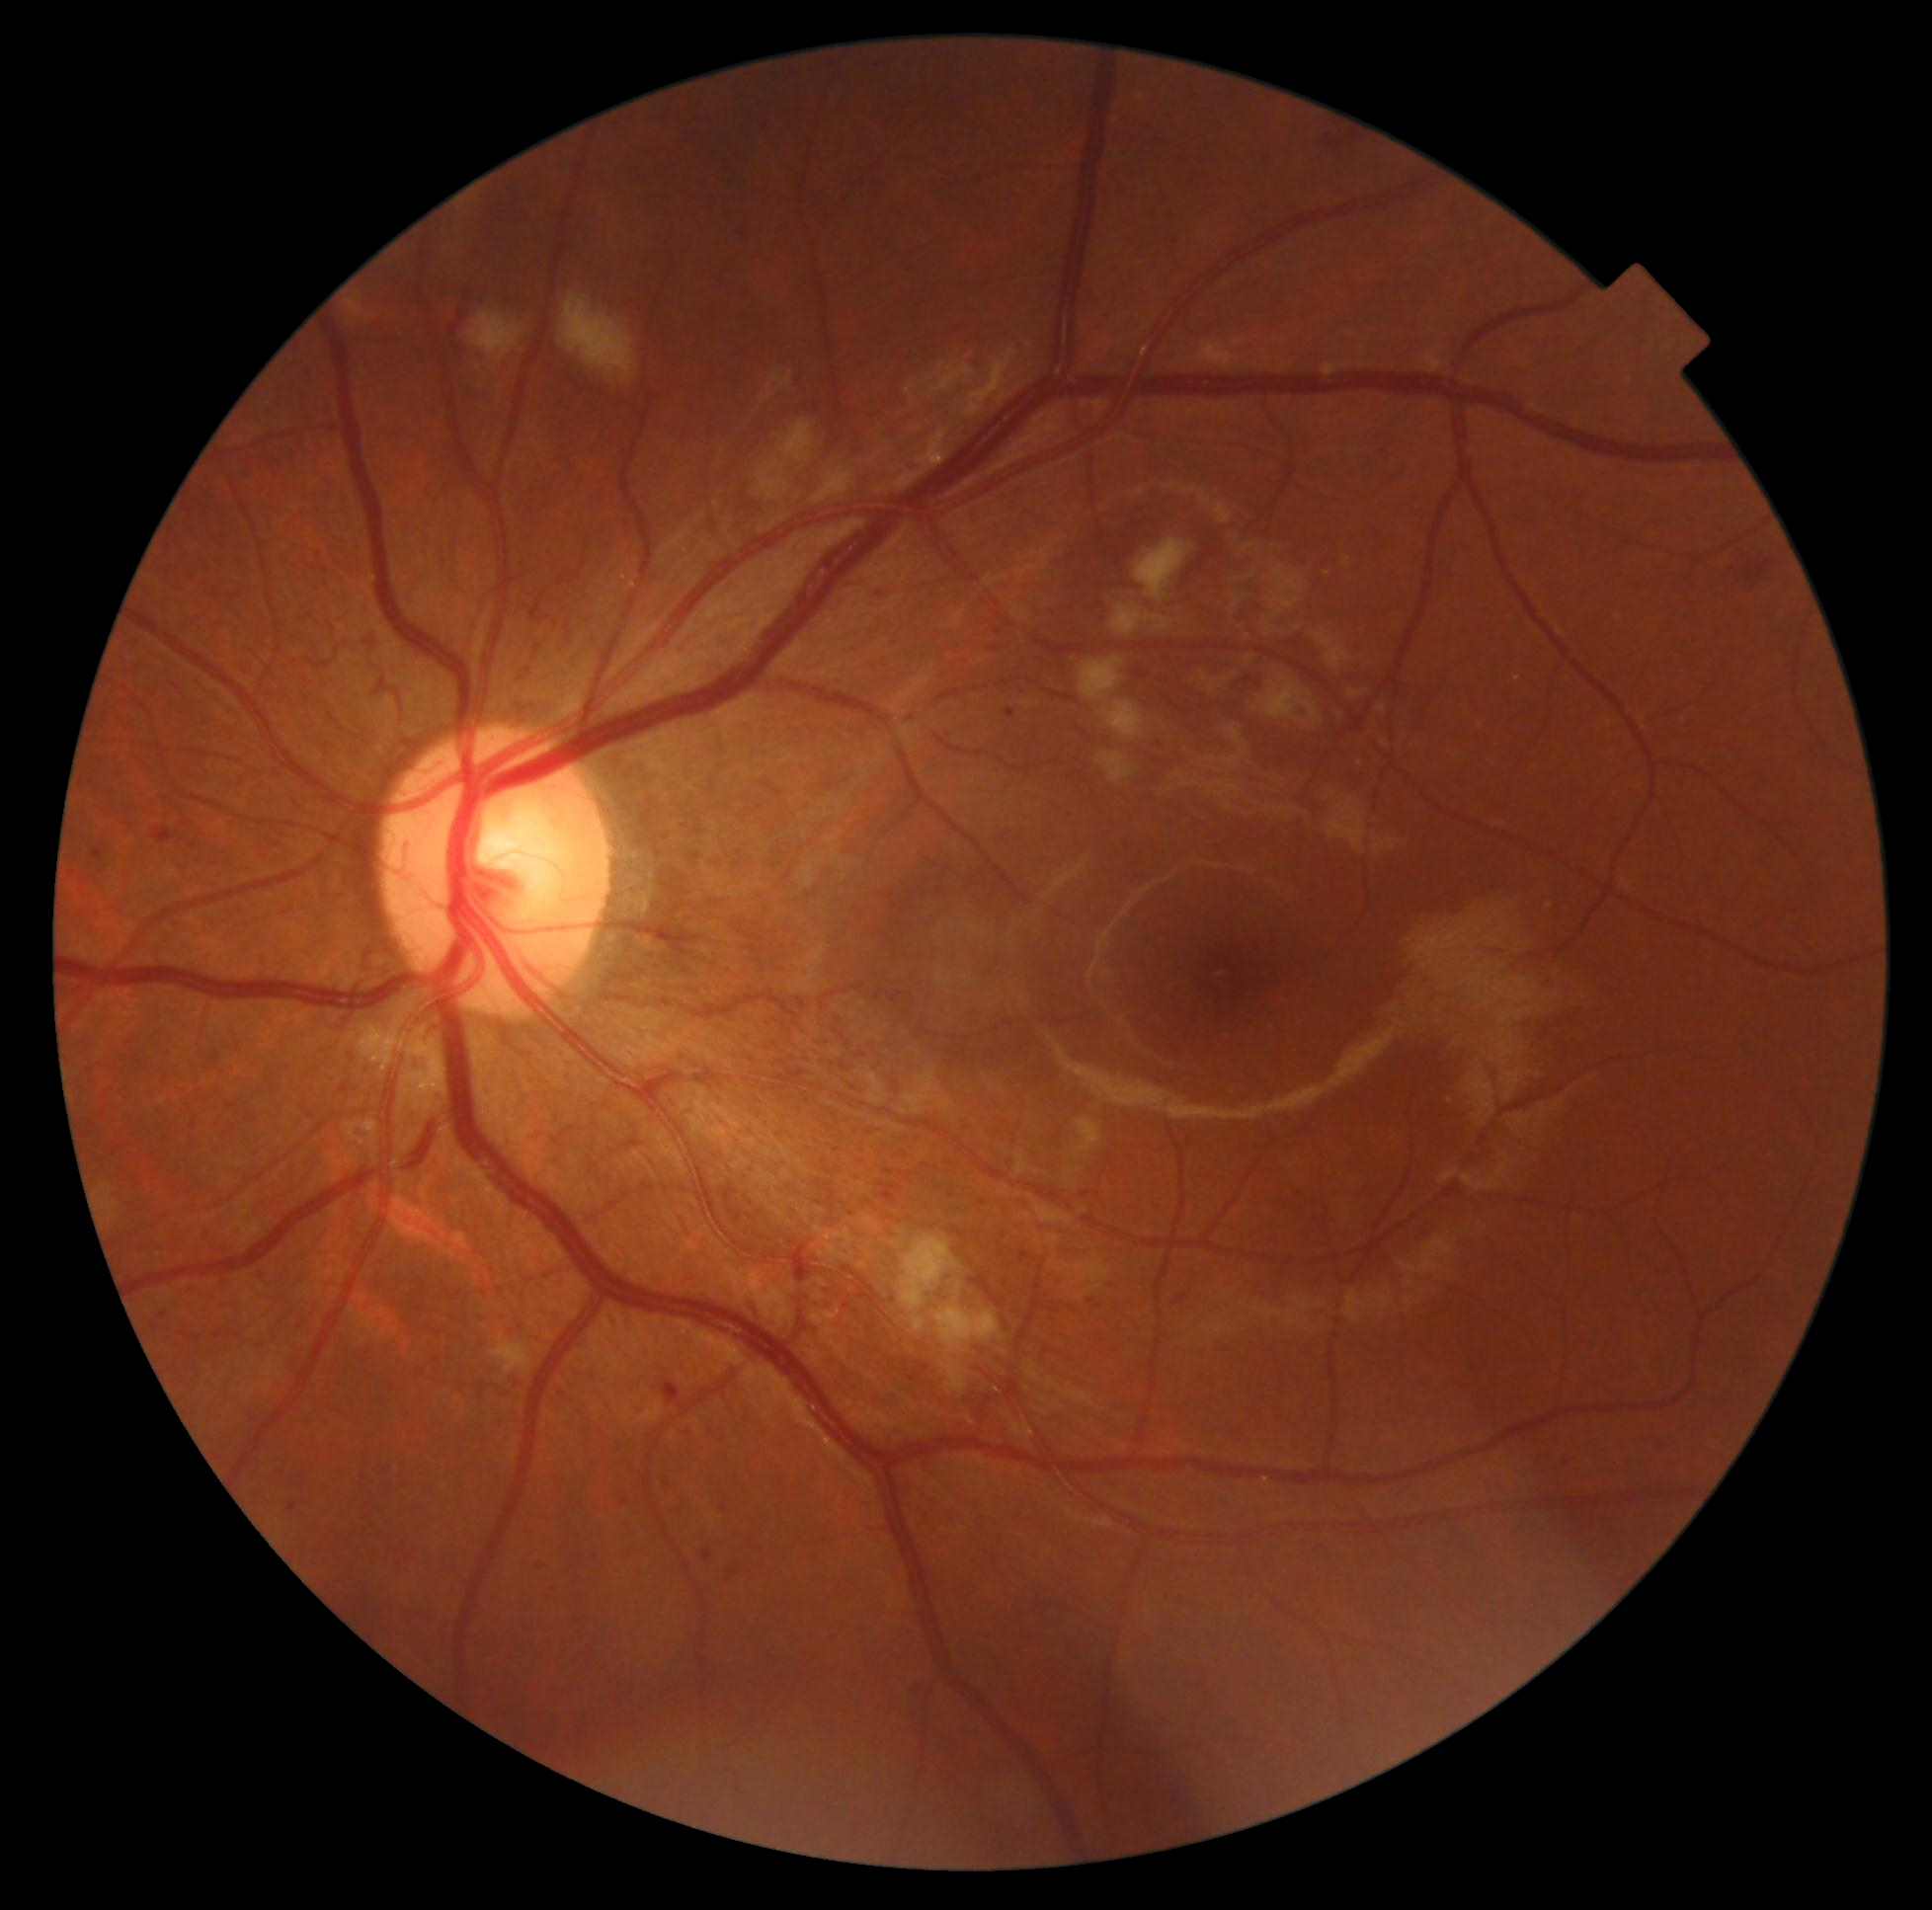

{"dr_grade": "3/4"}